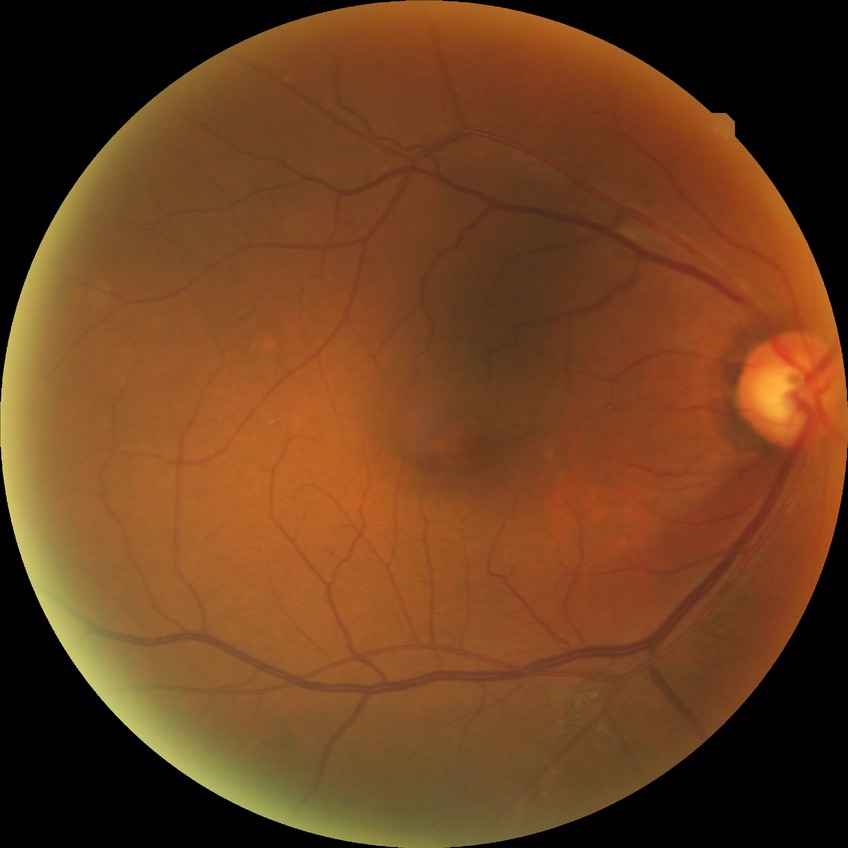
diabetic retinopathy (DR) = NDR (no diabetic retinopathy).